Pediatric retinal photograph (wide-field):
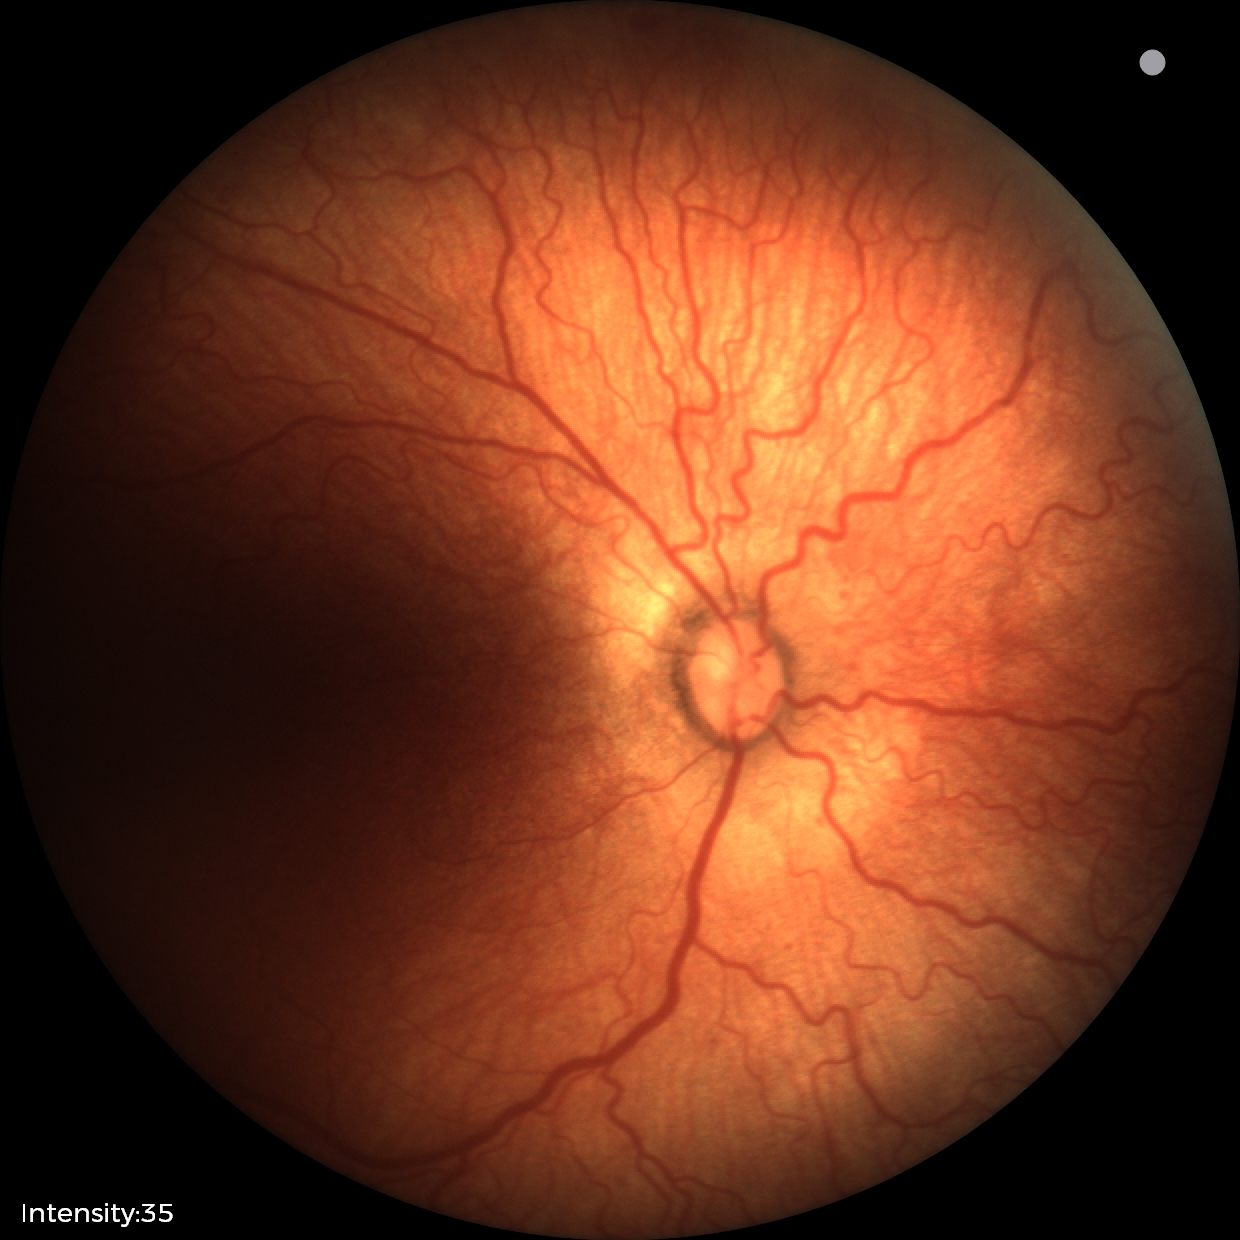 ROP diagnosis: stage 2 — ridge with height and width at the demarcation line, plus form: present.